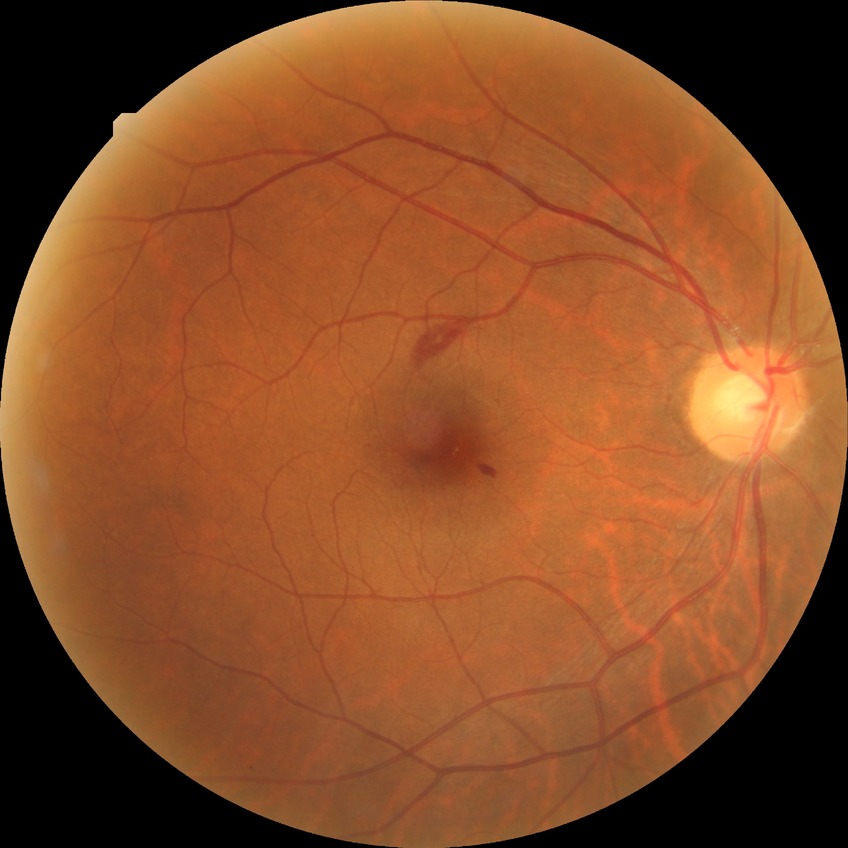 Diabetic retinopathy (DR): simple diabetic retinopathy (SDR).